Autorefraction: +0.25 -0.75 × 90°; color fundus photograph; captured on a Topcon TRC-NW400 fundus camera; axial length (AL): 23.86 mm; 72-year-old patient; woman; pachymetry 465 µm; intraocular pressure 19 mmHg.
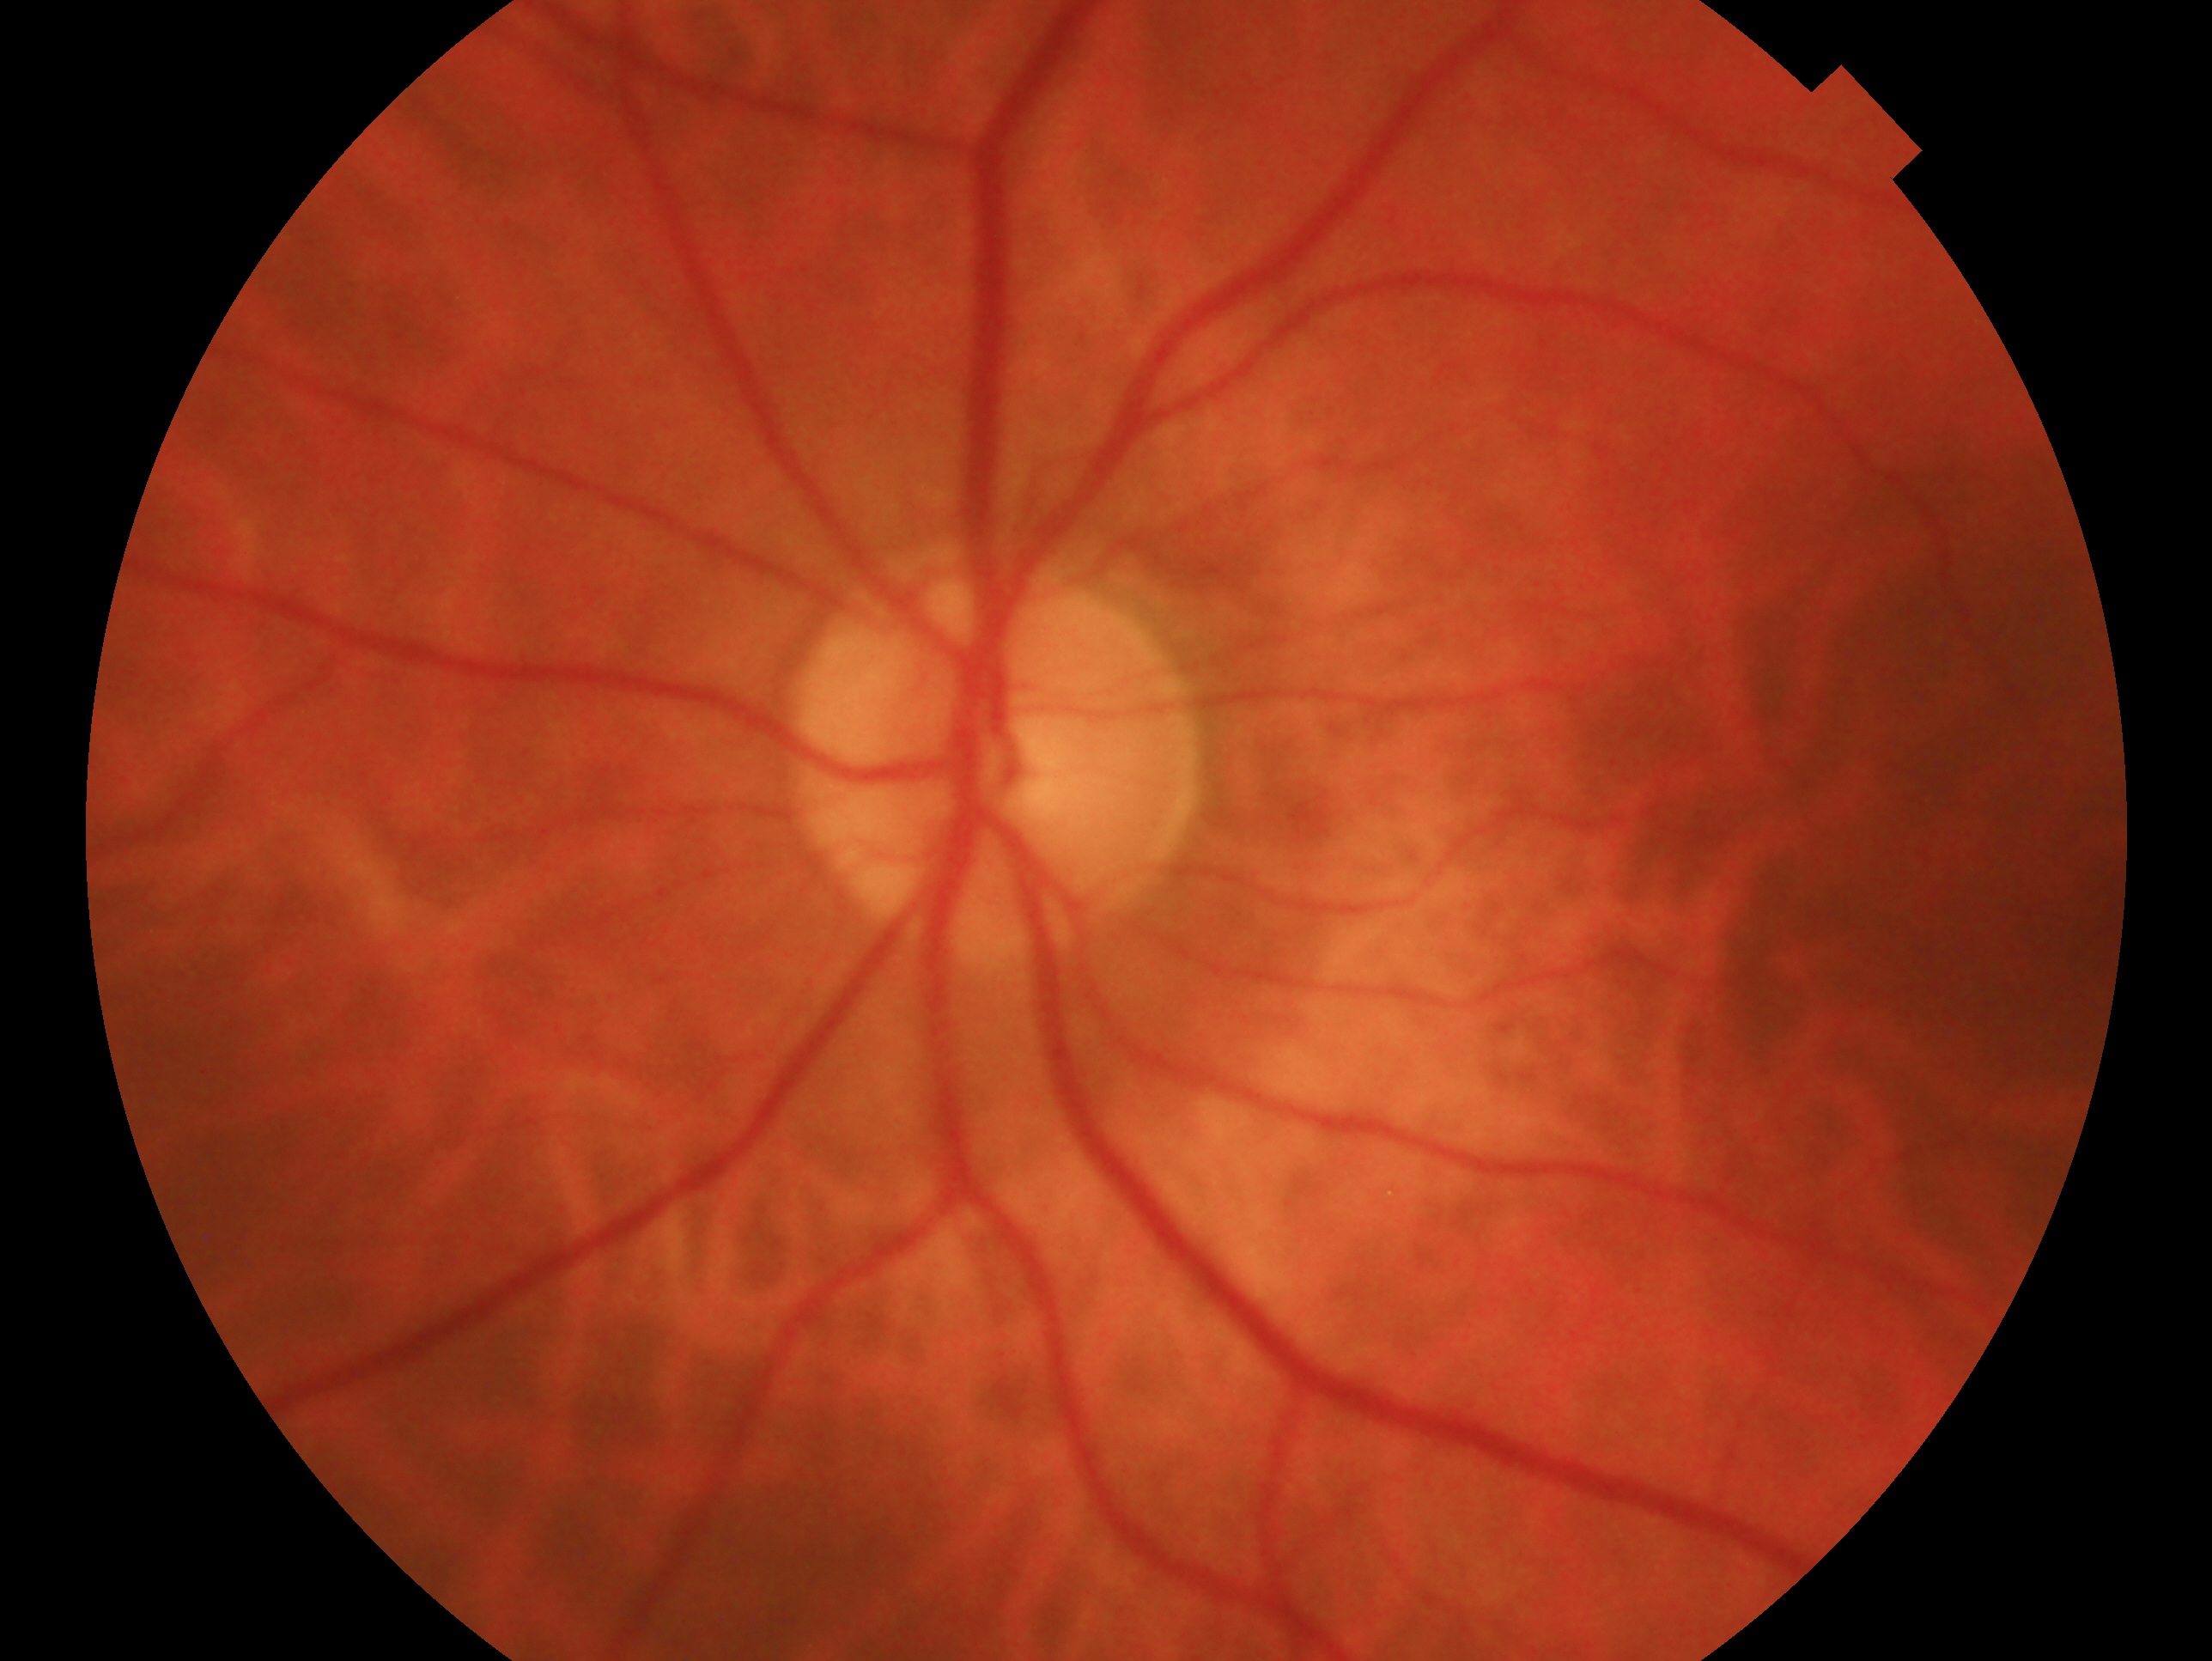

This is the left eye. Glaucoma status: negative for glaucoma — no clinical evidence of glaucoma in this eye.